Nonmydriatic
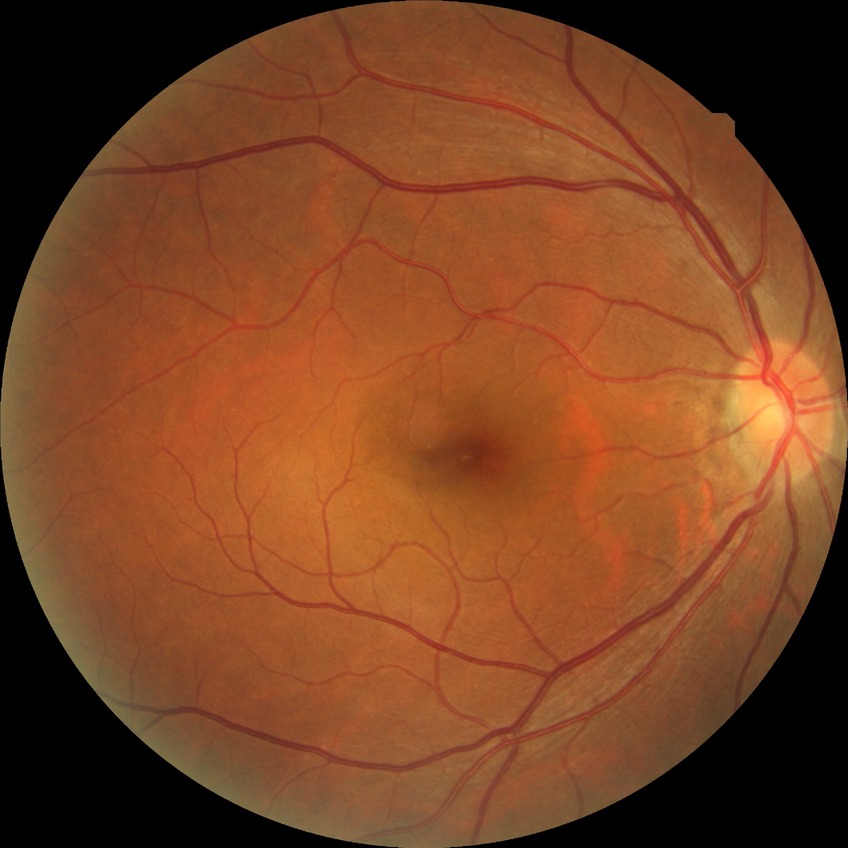

Davis grading is no diabetic retinopathy.